Infant wide-field retinal image. 100° field of view (Phoenix ICON). 1240x1240px:
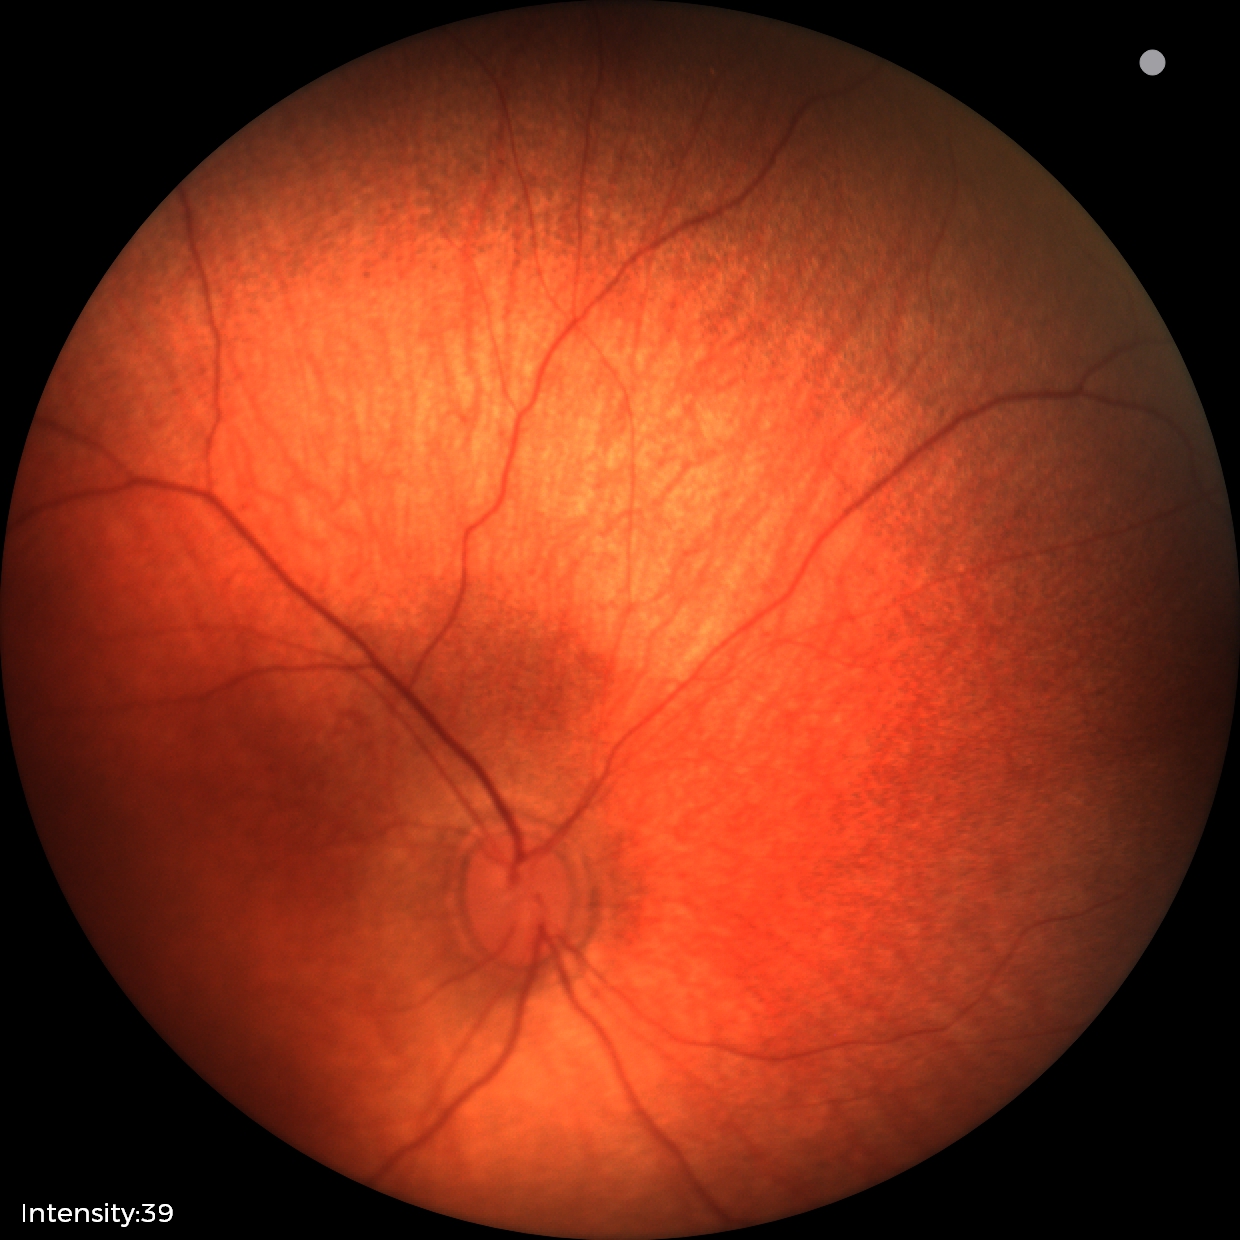 Screening diagnosis: normal retinal appearance.